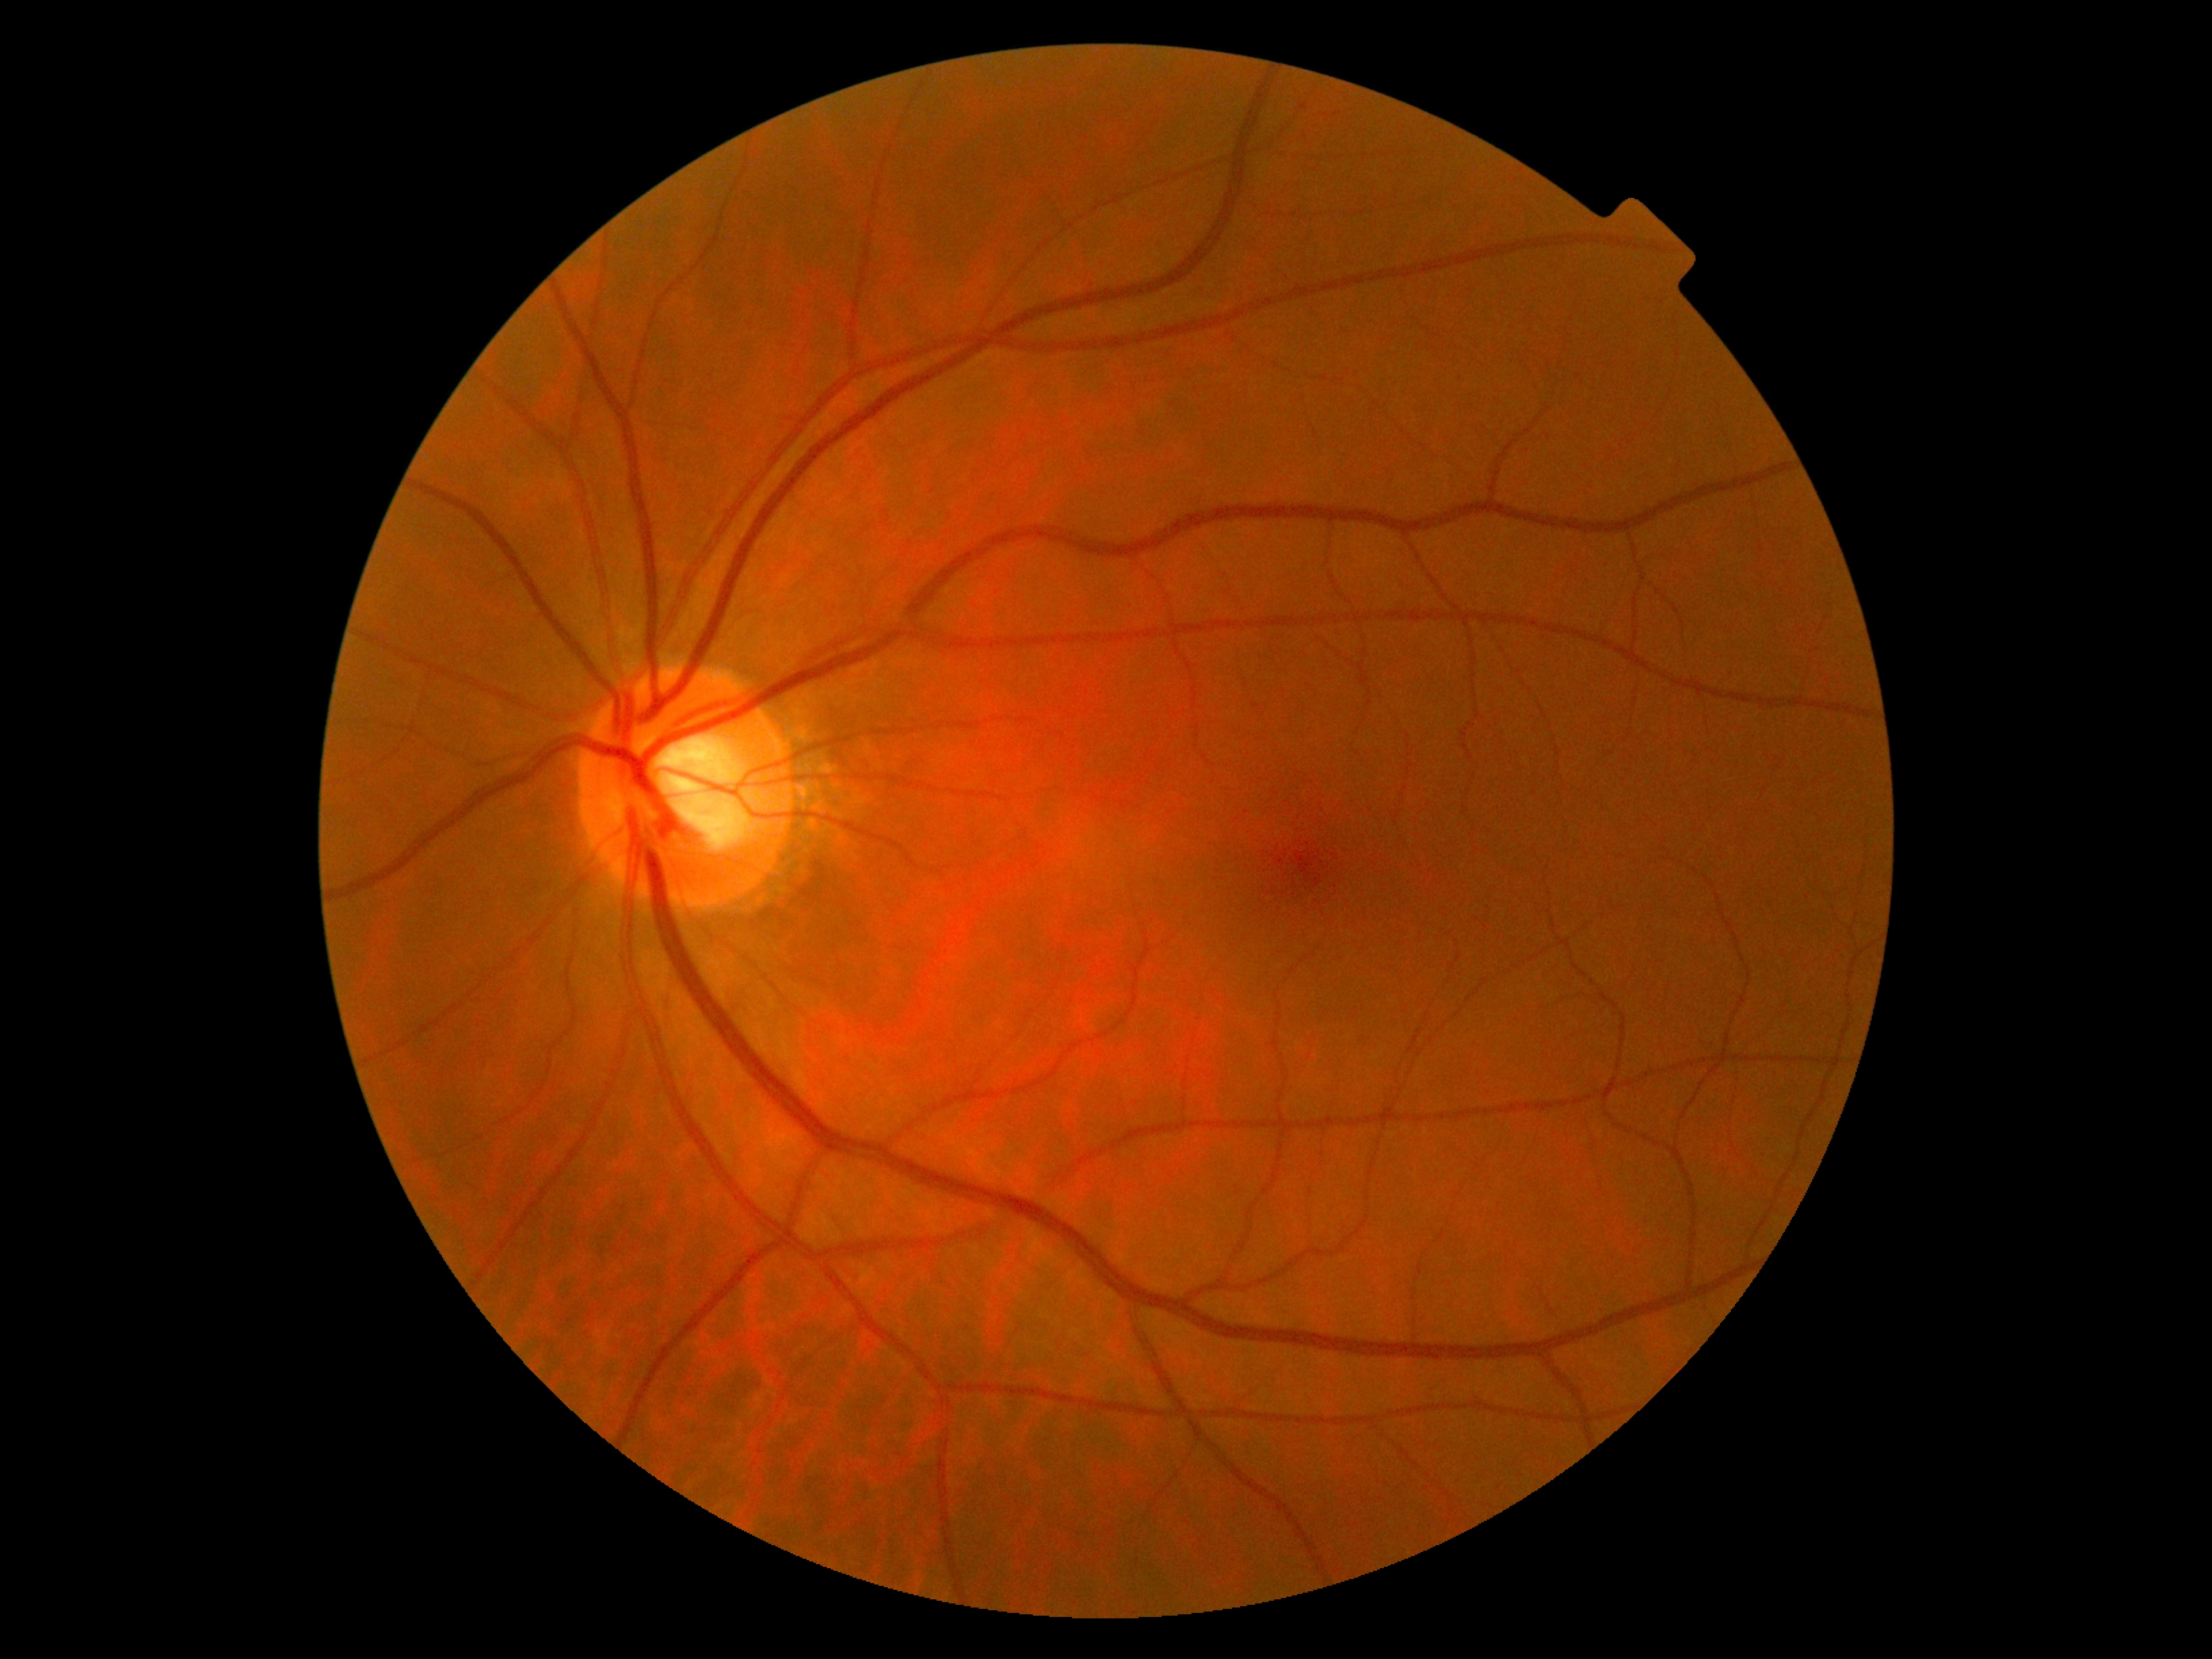 dr_grade: 0 — no visible signs of diabetic retinopathy